45° FOV.
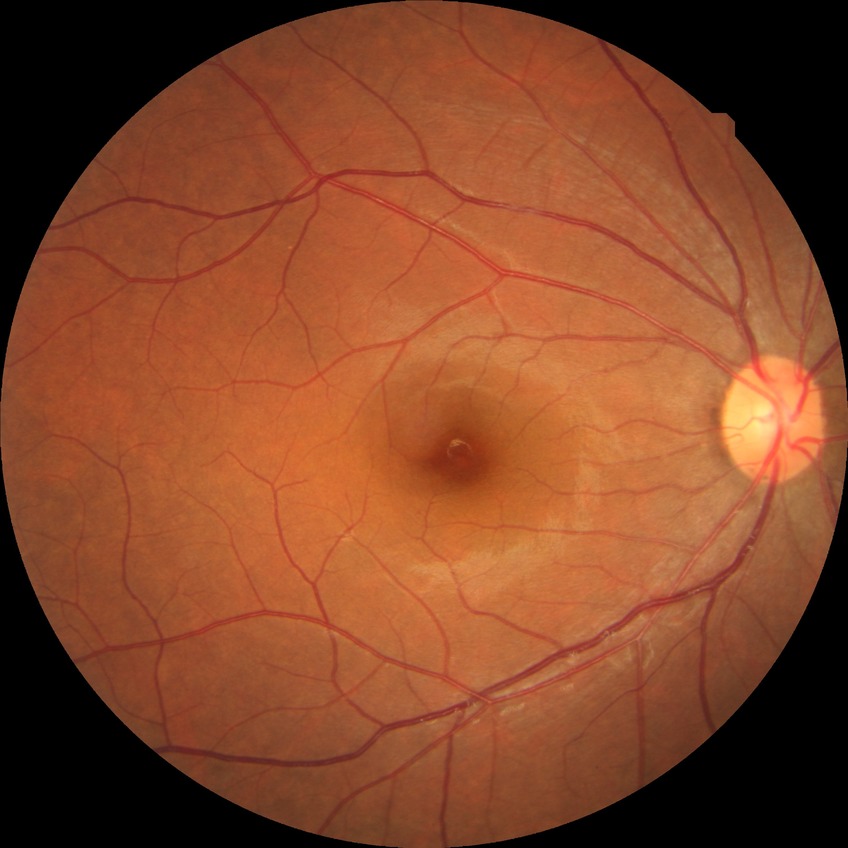 Diabetic retinopathy (DR) is no diabetic retinopathy (NDR).